Color fundus image
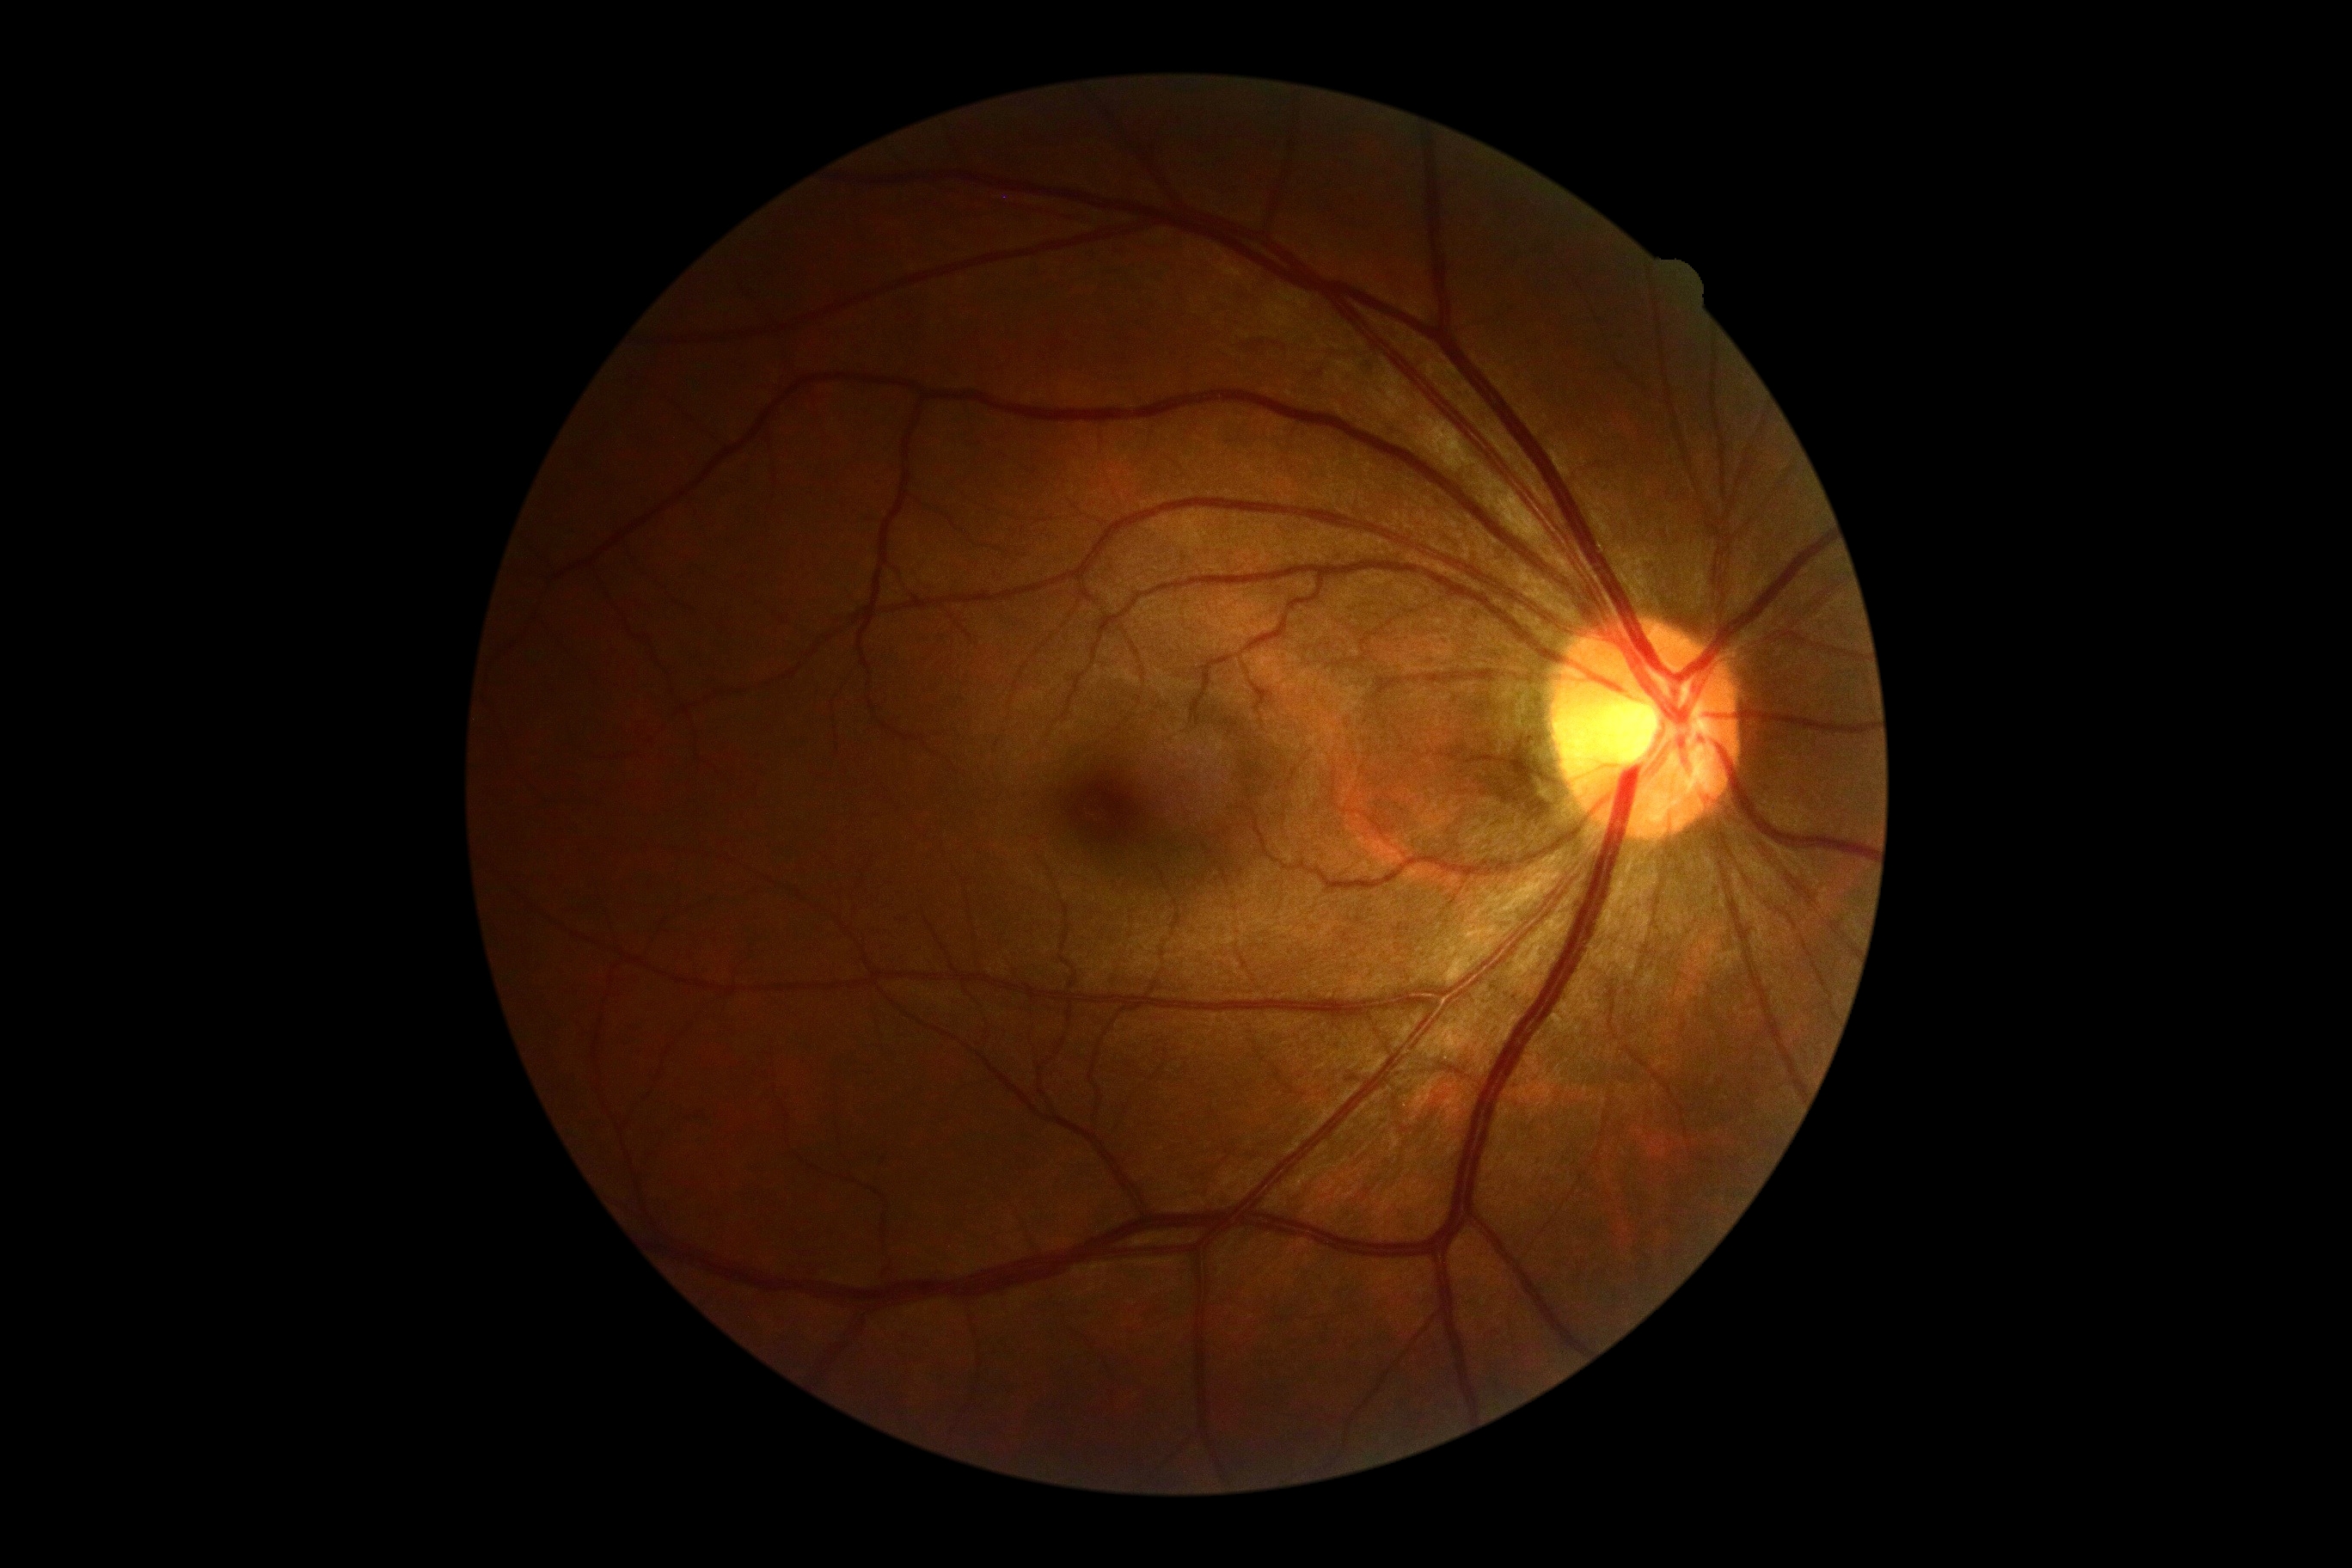
Retinopathy grade: no apparent retinopathy (0).